Disc-centered fundus crop — 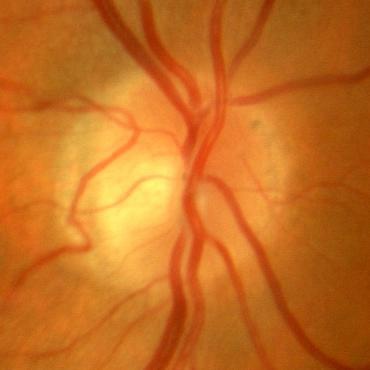
No evidence of glaucoma.